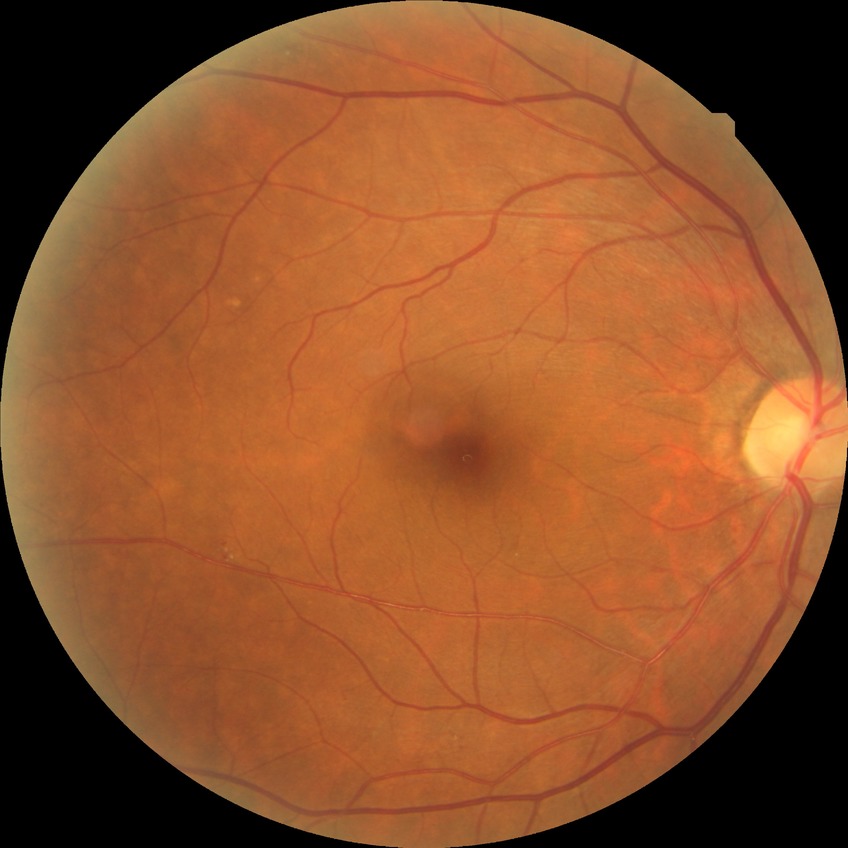
diabetic retinopathy severity@no diabetic retinopathy.